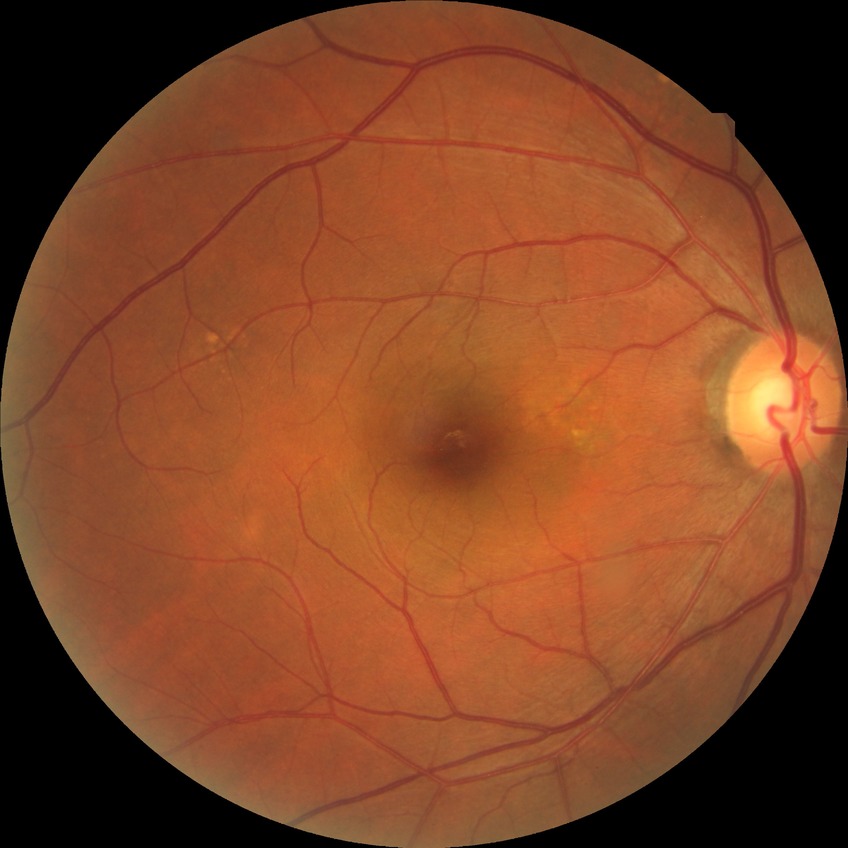
DR@NDR.